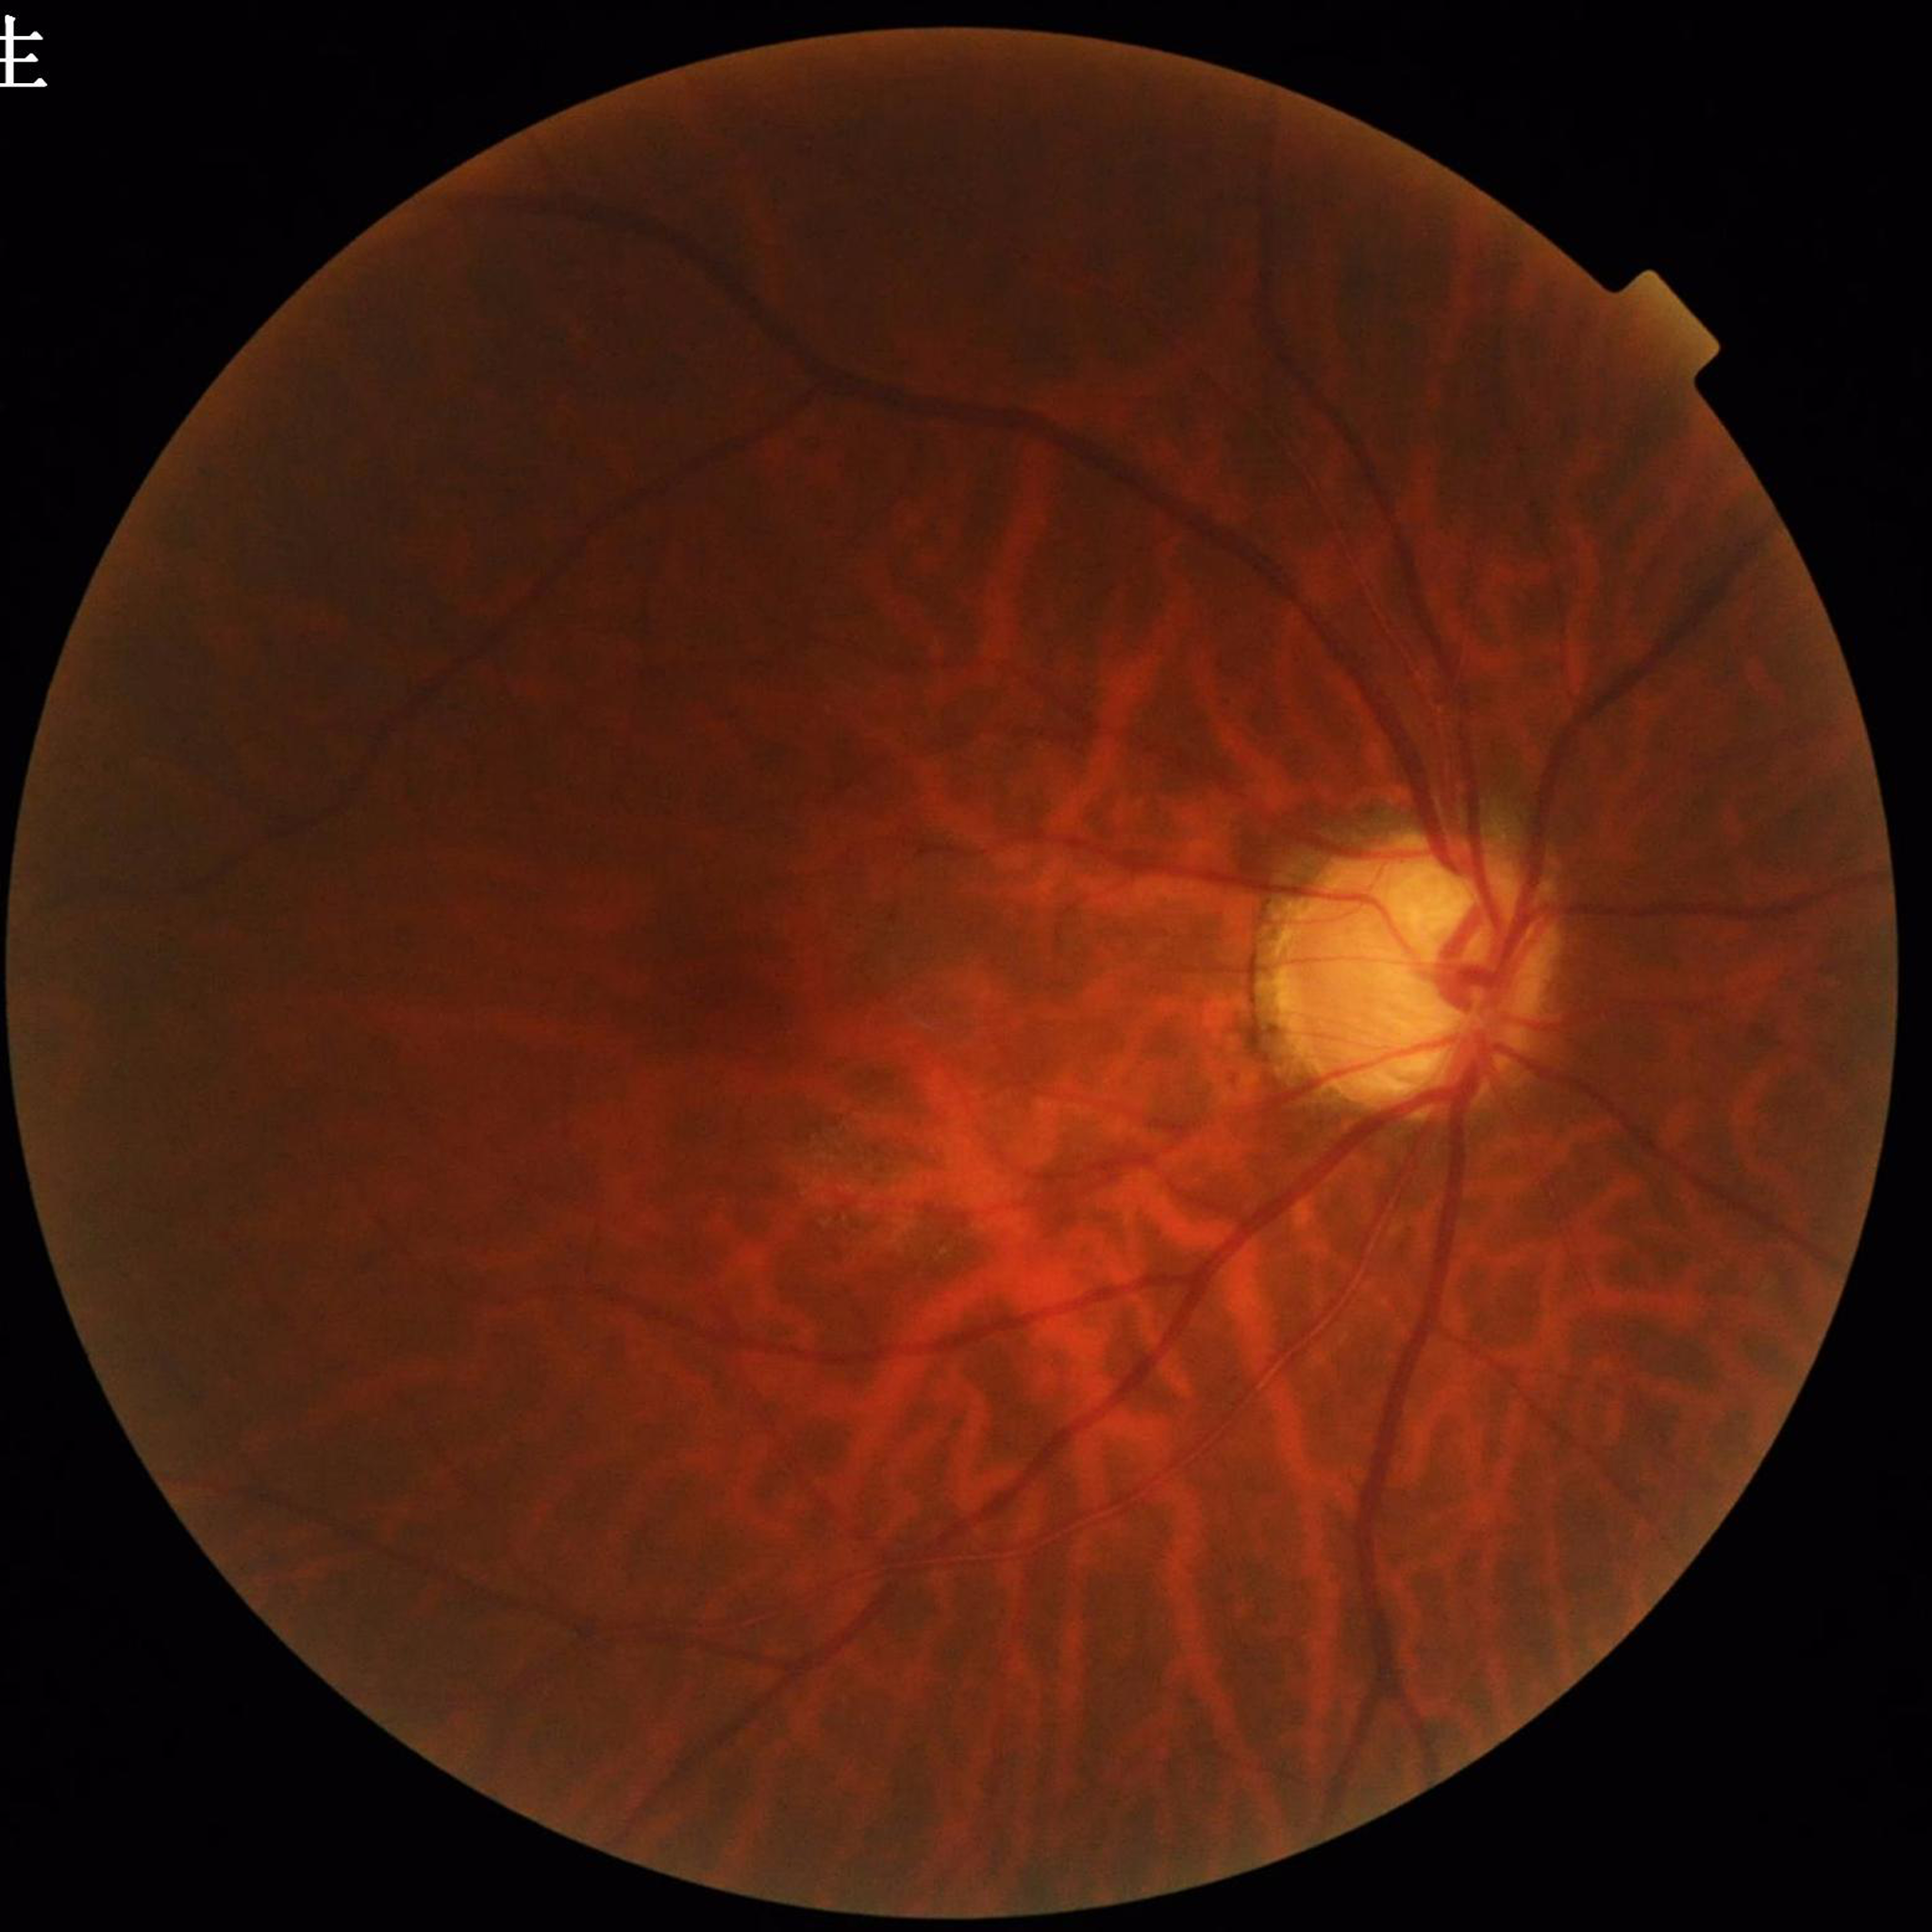
Quality: no quality issues identified. Retinal fundus photograph from a patient with glaucoma.